Modified Davis grading. Posterior pole photograph:
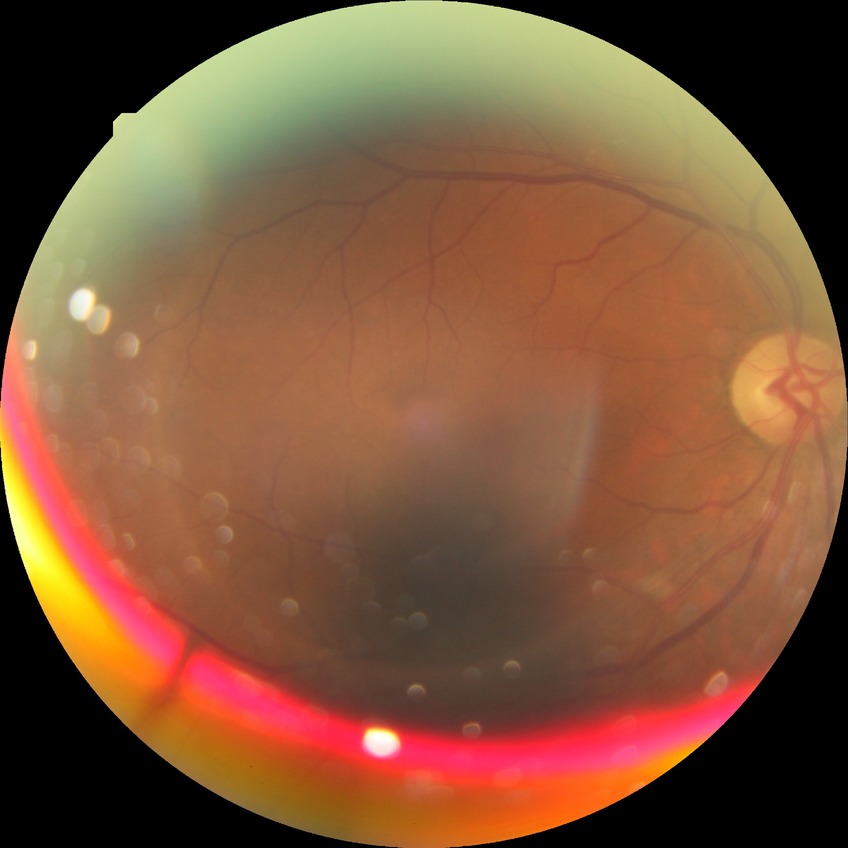

Diabetic retinopathy (DR): NDR (no diabetic retinopathy).